Color fundus photograph from a handheld portable camera:
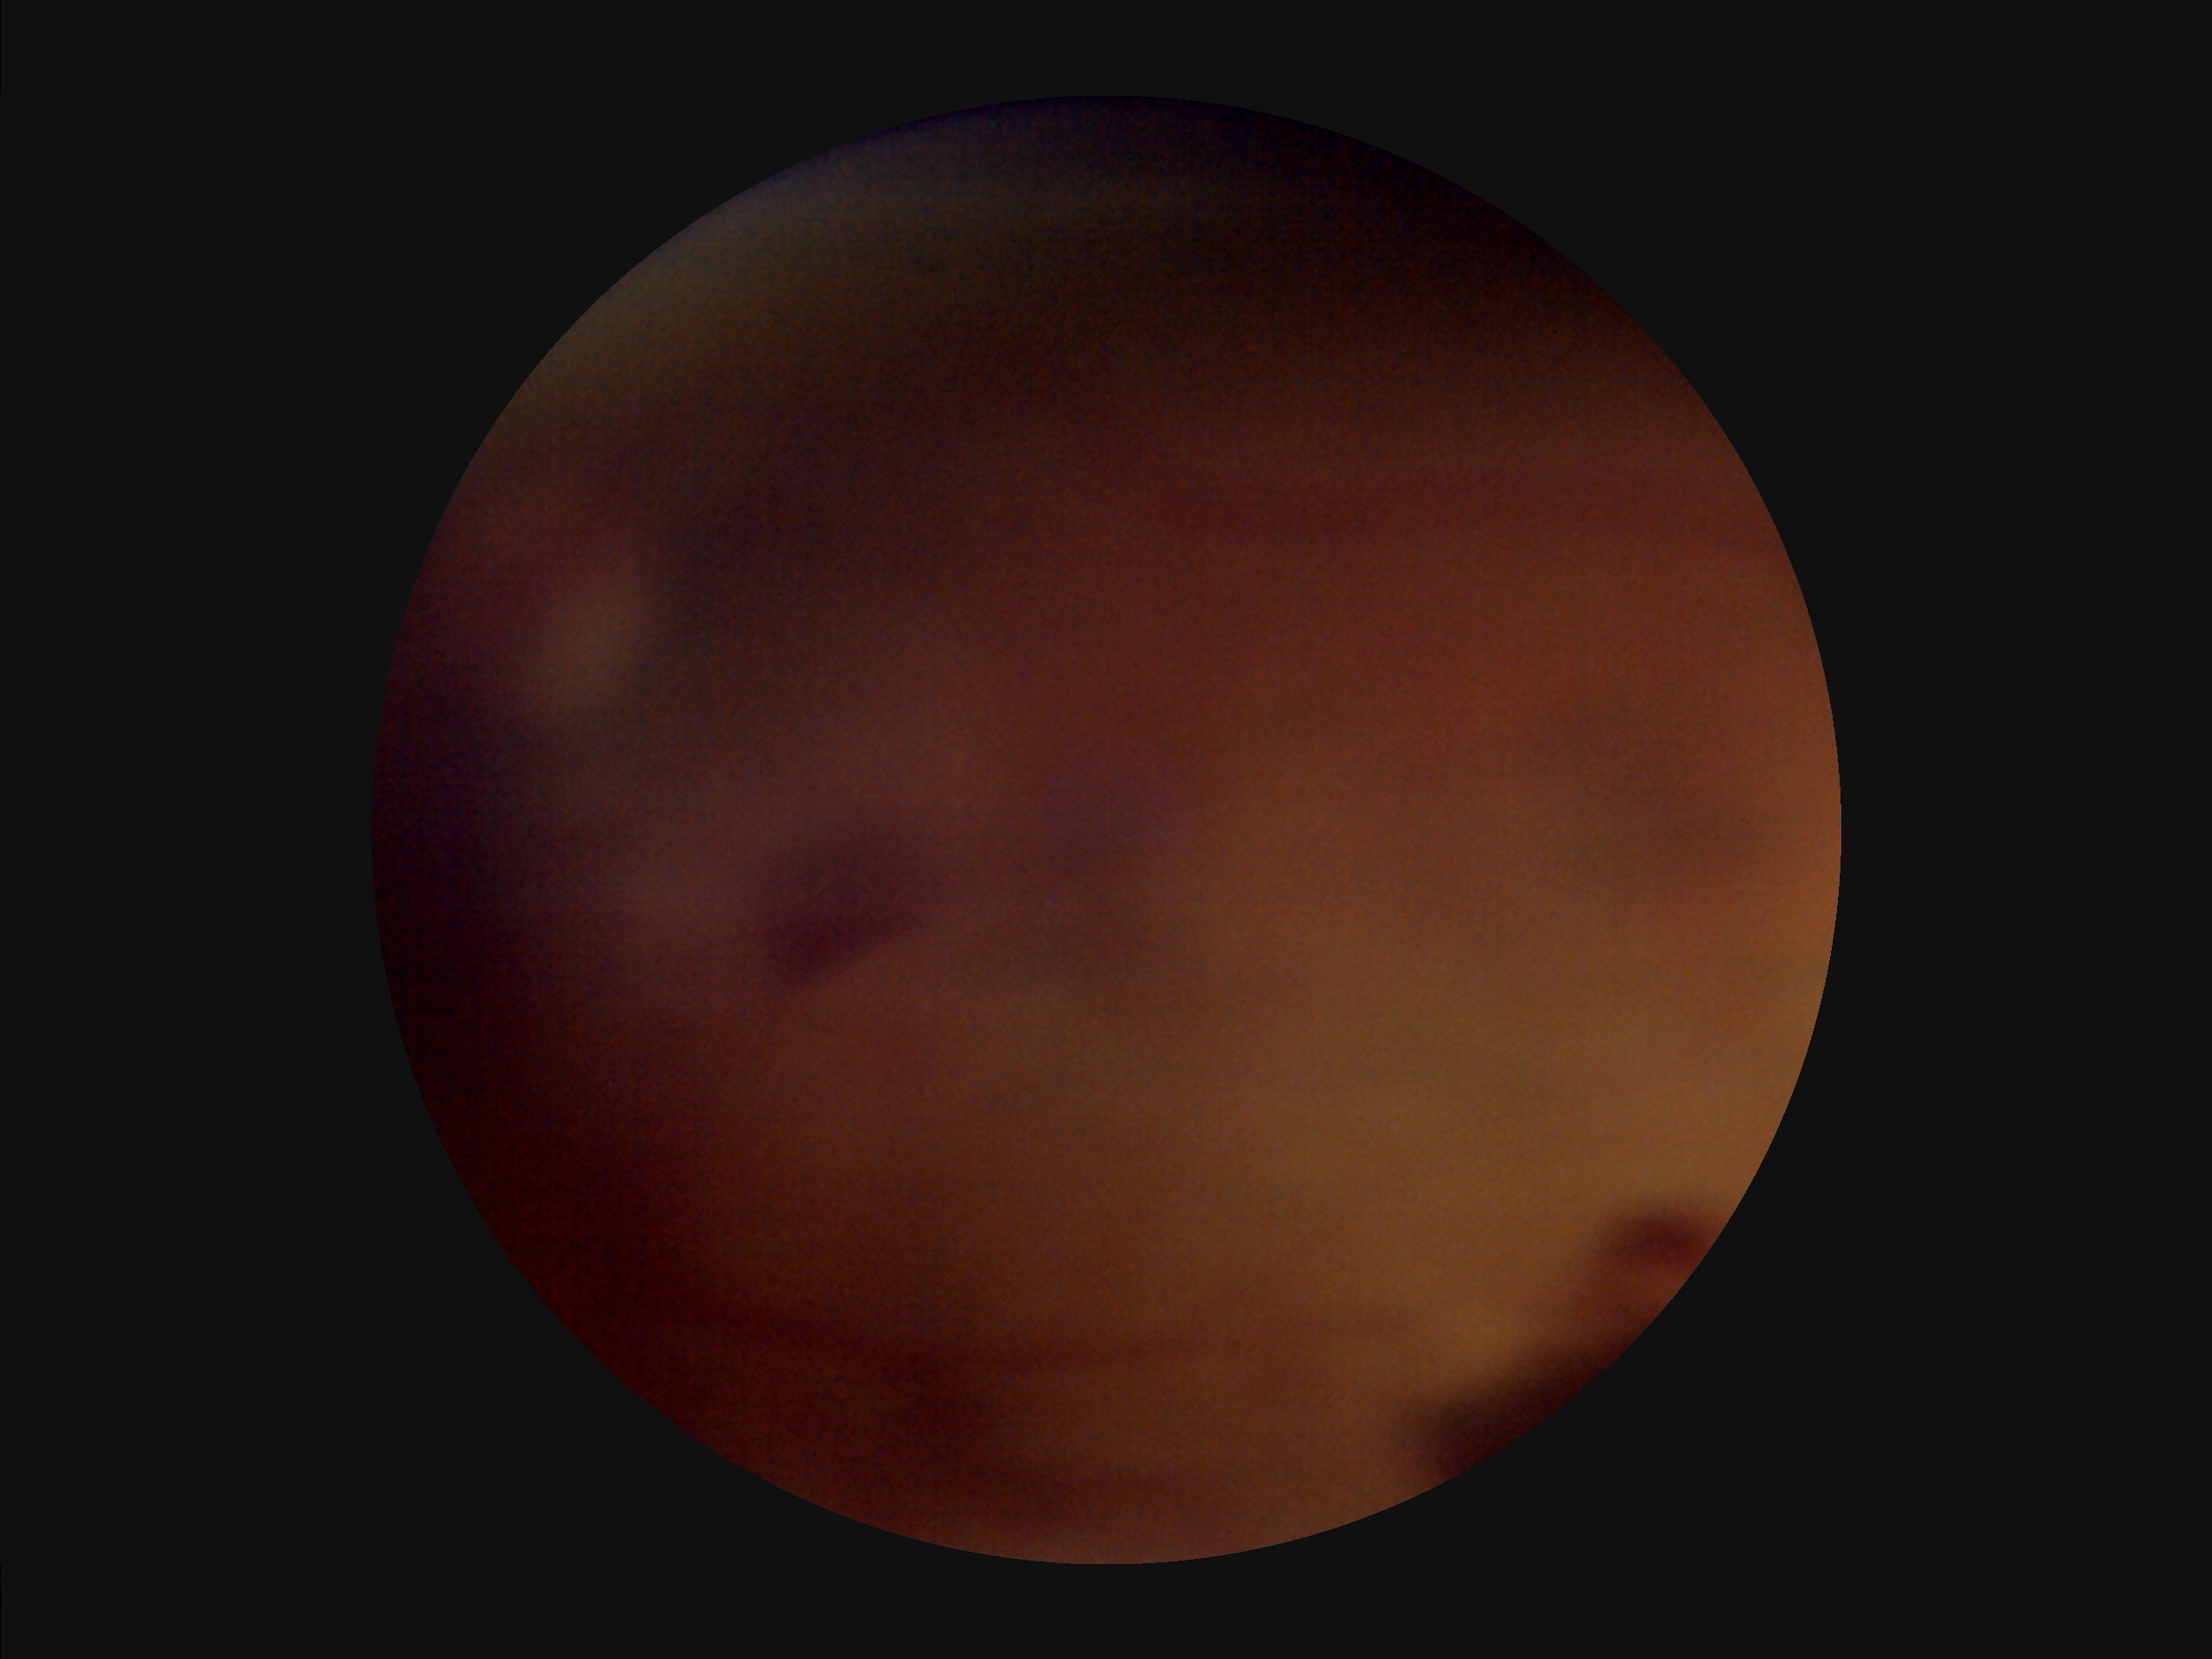 Noticeable blur in the optic disc, vessels, or background. Poor dynamic range. There is over- or under-exposure or a color cast. Image quality is inadequate for diagnostic use.